Color fundus photograph — 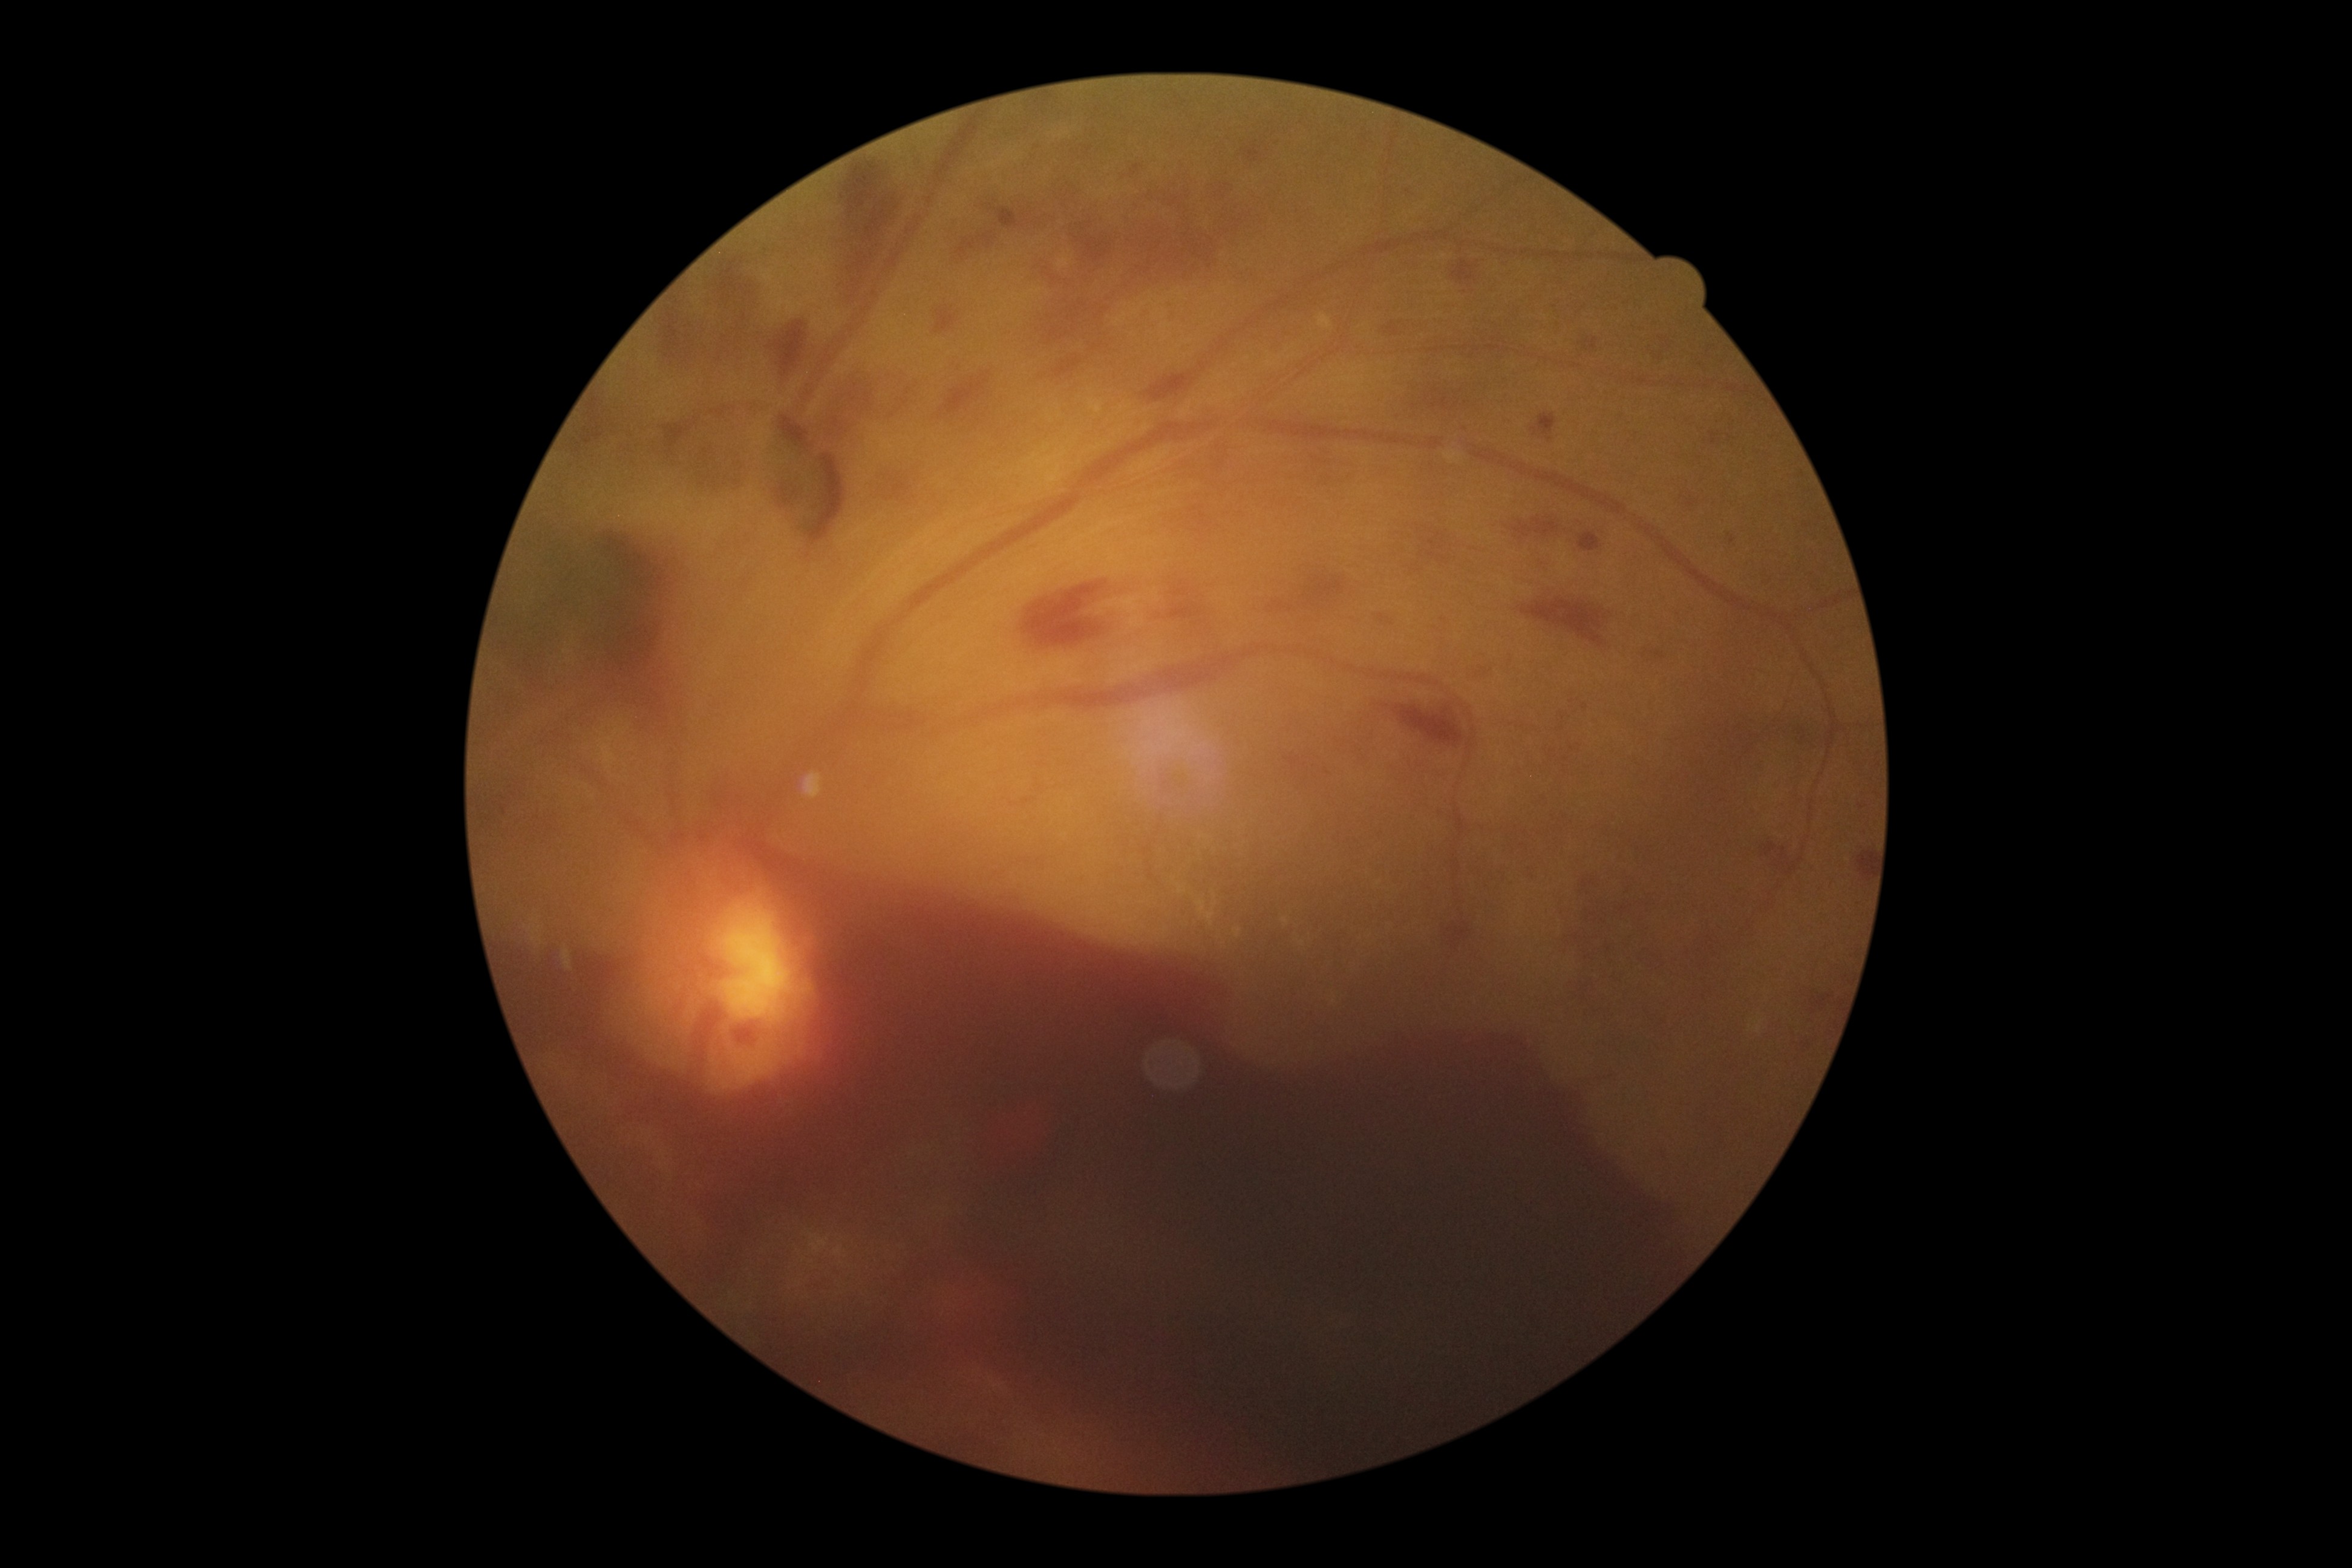
Diabetic retinopathy (DR) is 4/4 — neovascularization and/or vitreous/pre-retinal hemorrhage.